Cropped to the optic nerve head; captured without pupil dilation; 240 by 240 pixels
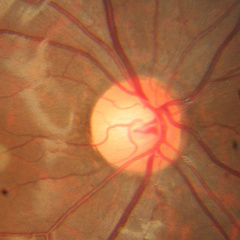
No signs of glaucoma.